Acquired with a NIDEK AFC-230, no pharmacologic dilation, color fundus image, 848x848px, 45 degree fundus photograph:
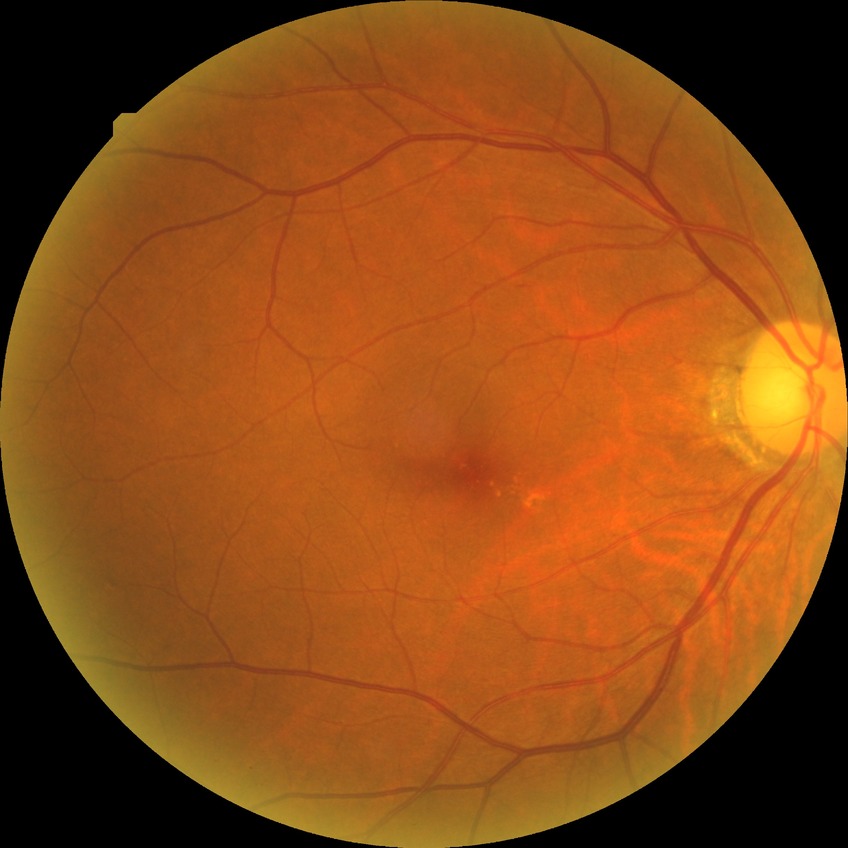
retinopathy stage: no diabetic retinopathy.